Infant wide-field retinal image; image size 640x480; 130° field of view (Clarity RetCam 3).
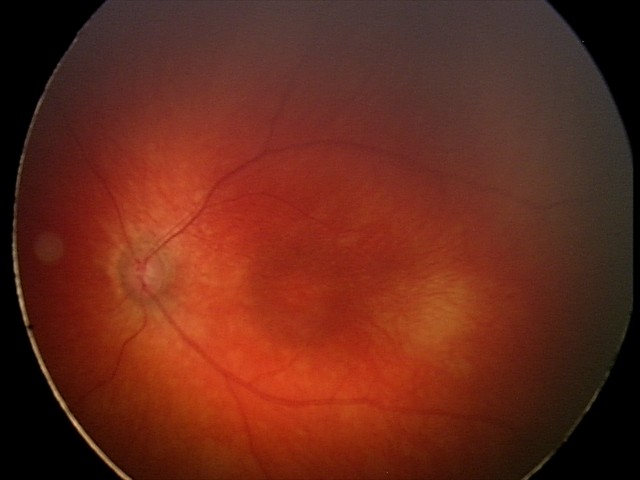 Screening series with retinal hemorrhages.